Color fundus image.
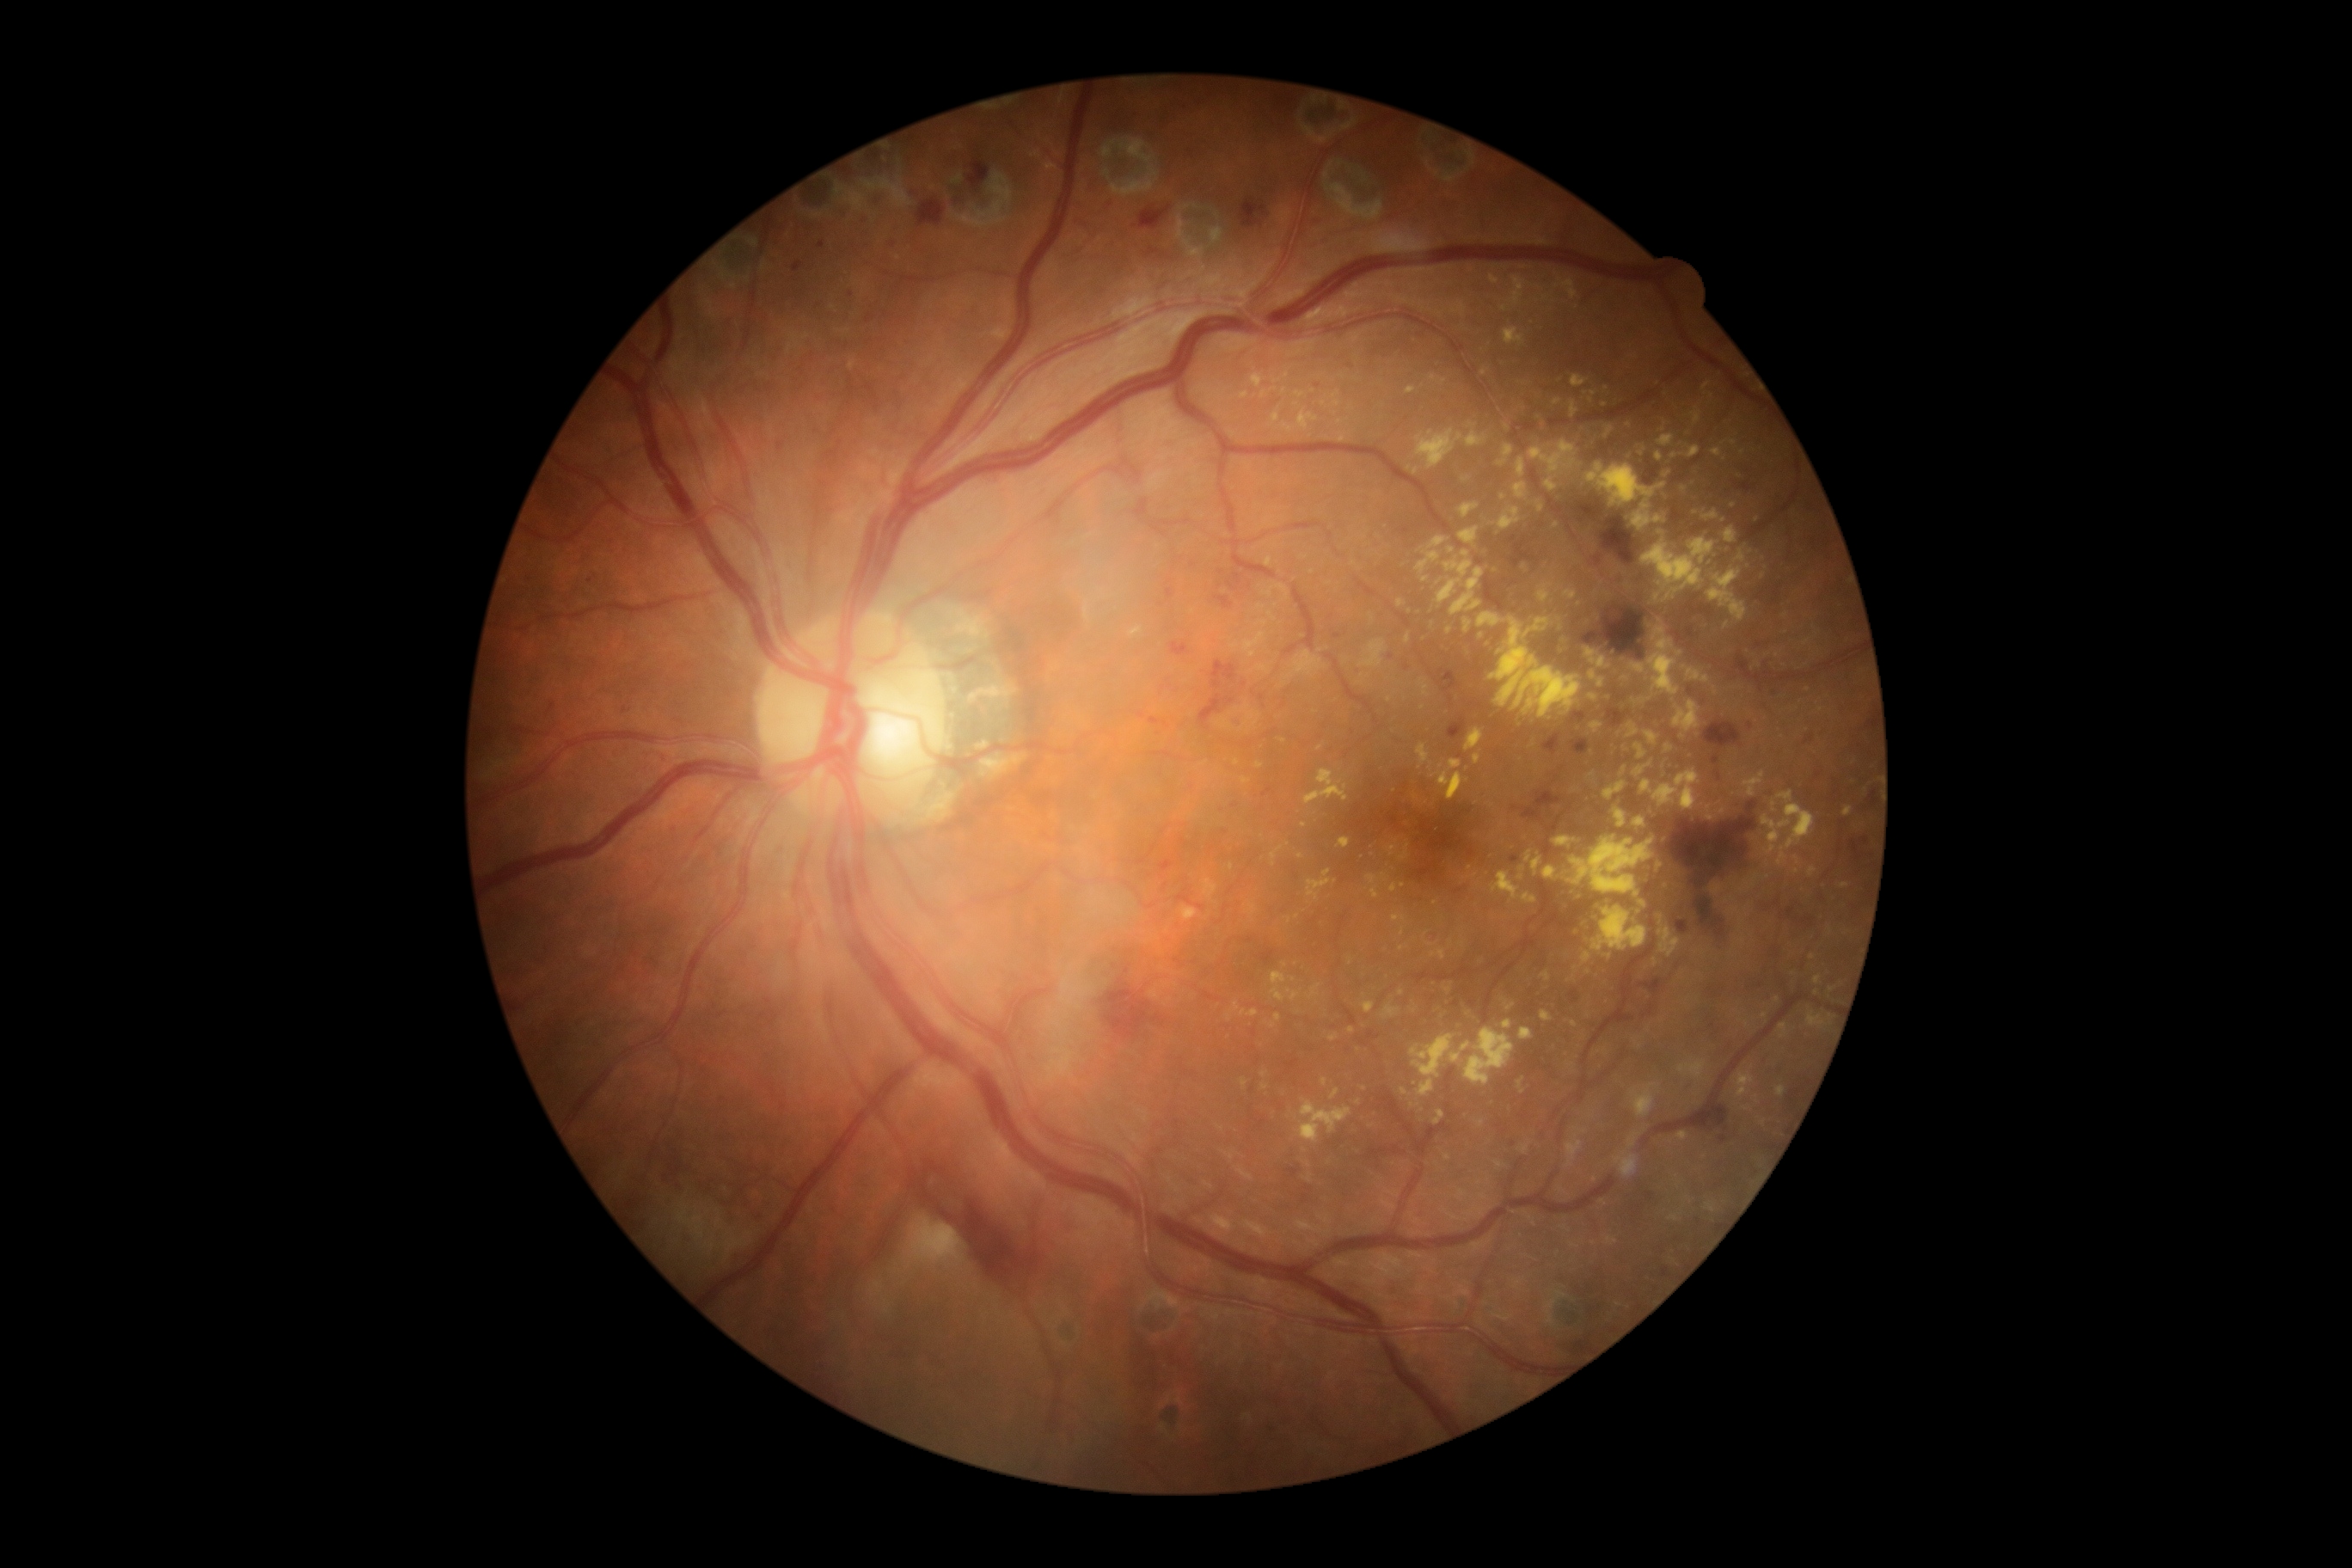 DR grade: 2.